Camera: Clarity RetCam 3 (130° FOV). Pediatric retinal photograph (wide-field). 640x480: 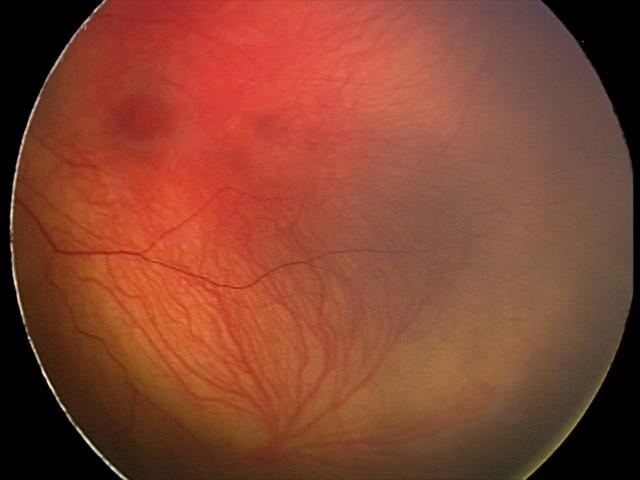 Screening series with status post retinopathy of prematurity — retinal appearance after treated retinopathy of prematurity.